Captured without pupil dilation — 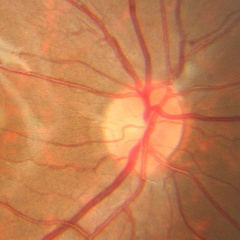 Color fundus photograph showing no evidence of glaucoma.